Retinal fundus photograph
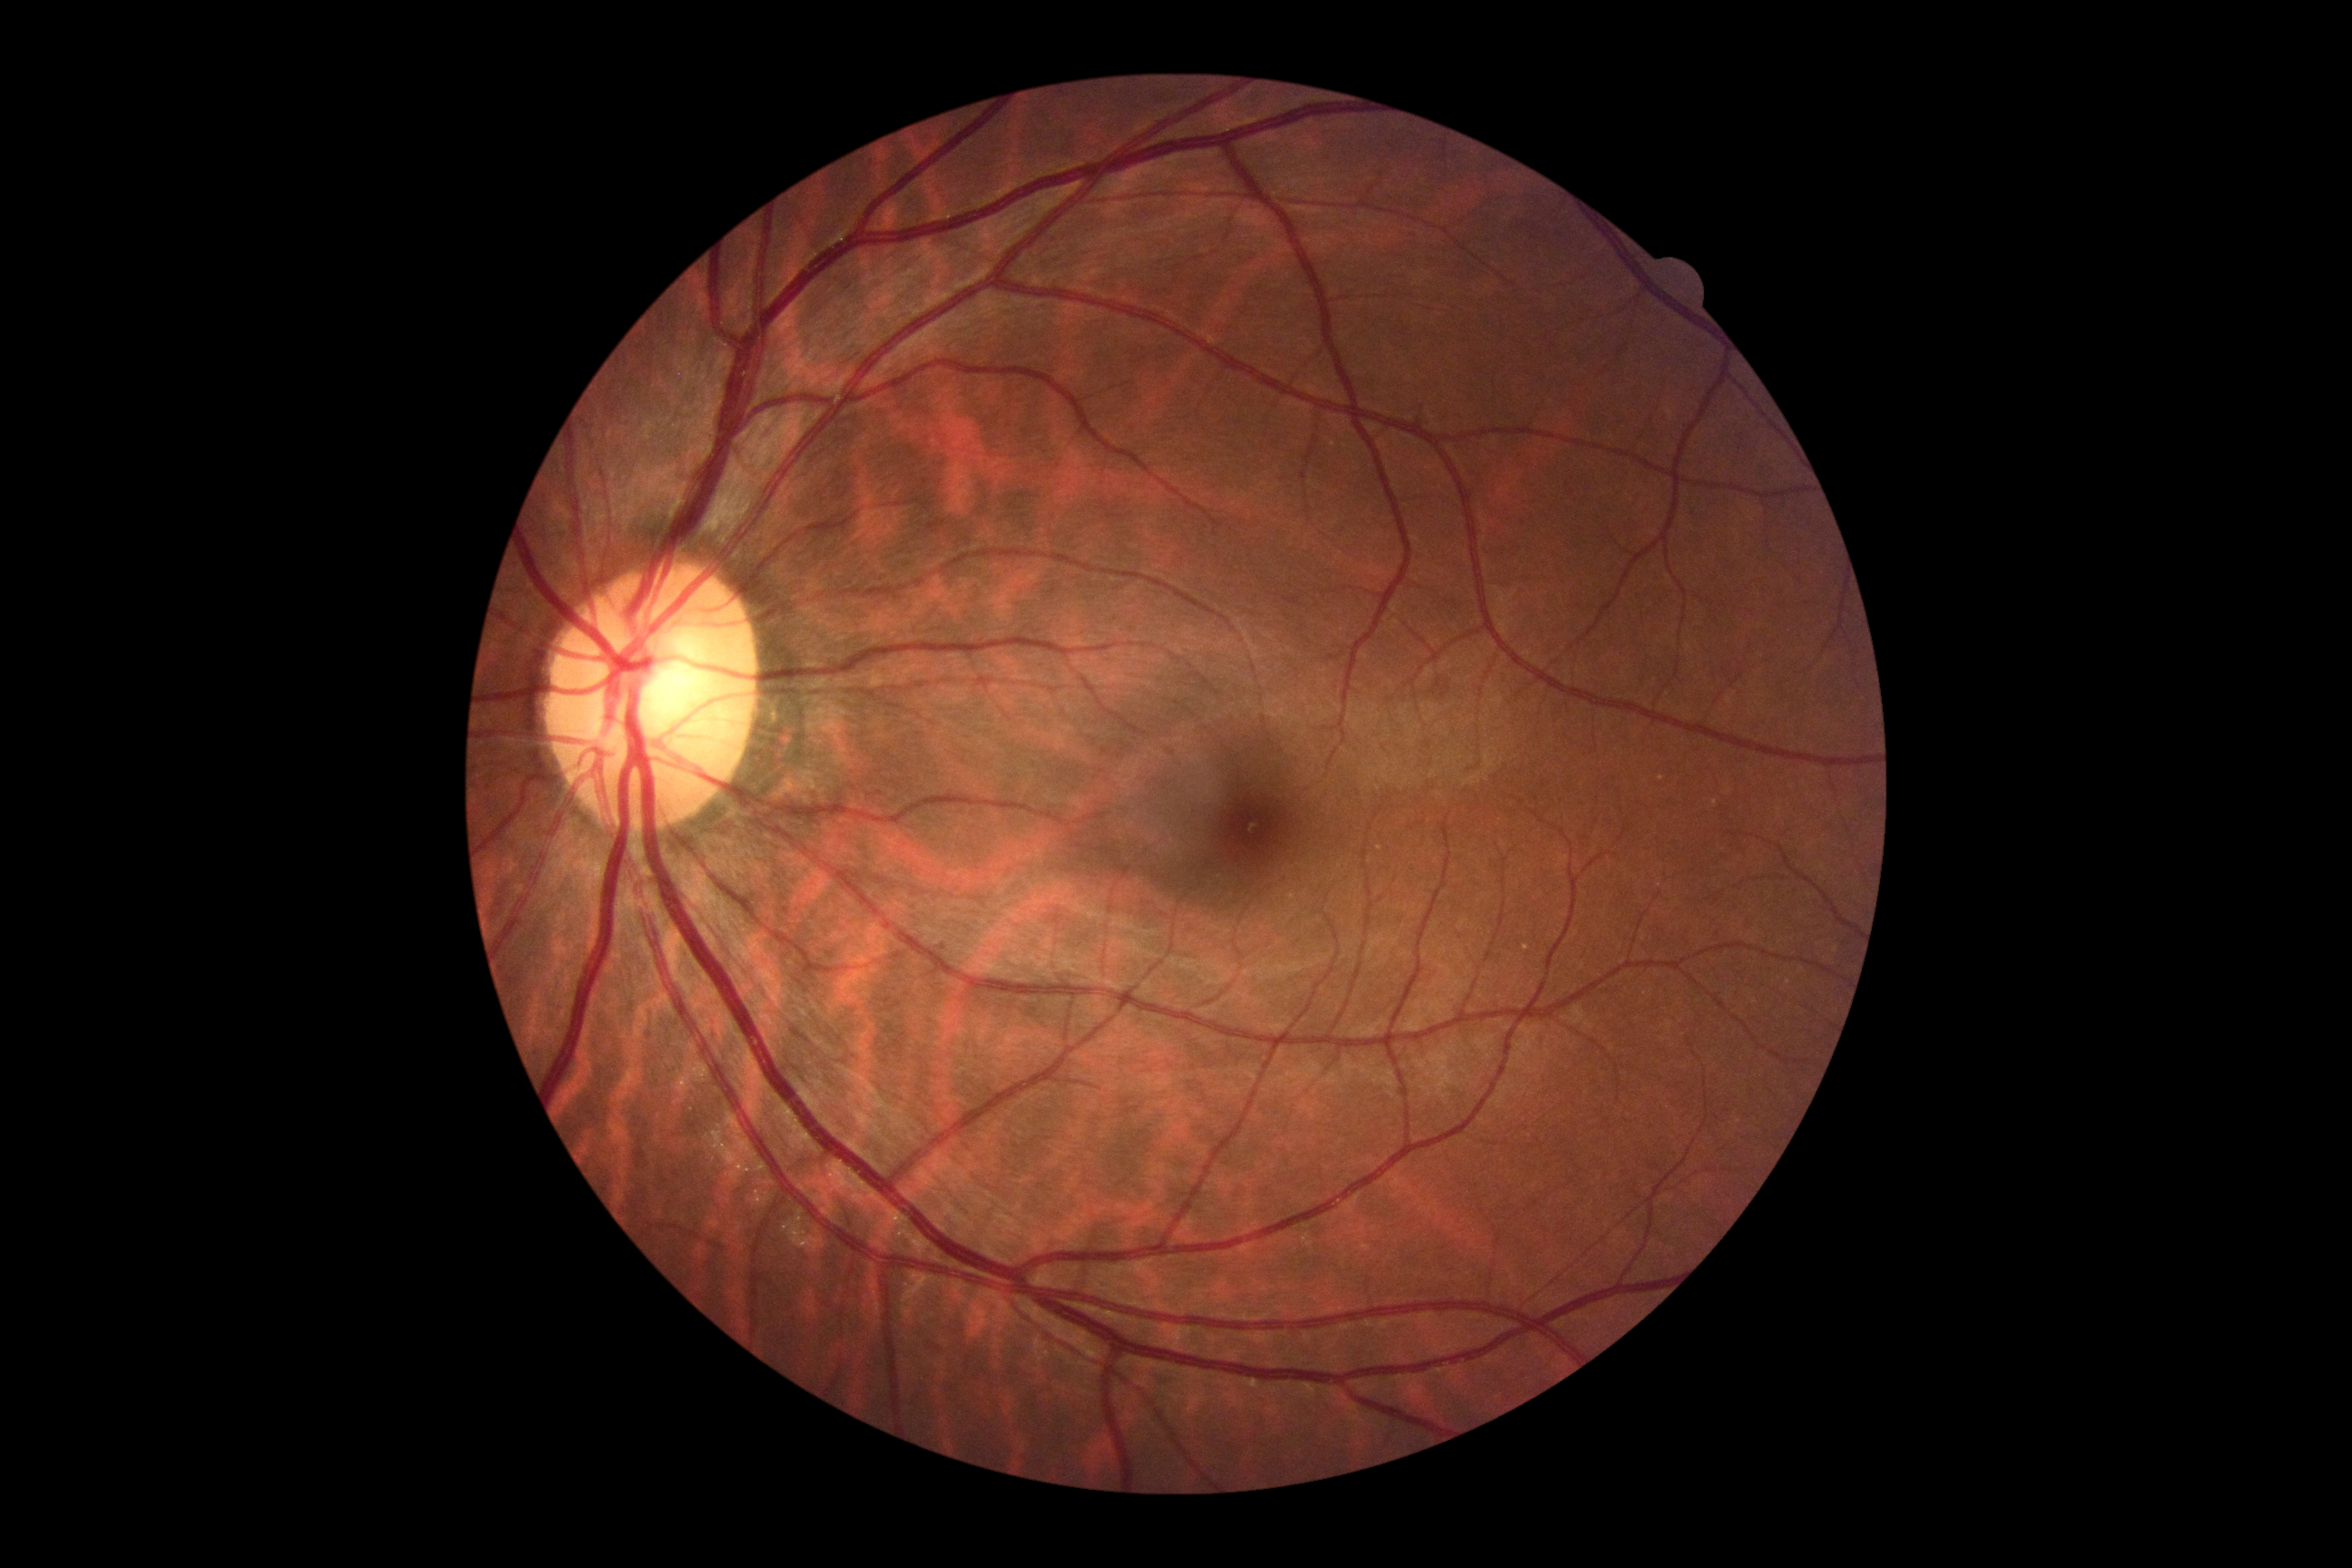
Diabetic retinopathy (DR) is no apparent retinopathy (grade 0).